Optic nerve head photograph; Topcon TRC retinal camera, IMAGEnet capture system: 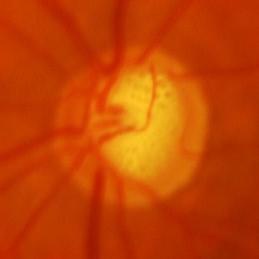

Findings consistent with glaucomatous optic neuropathy.